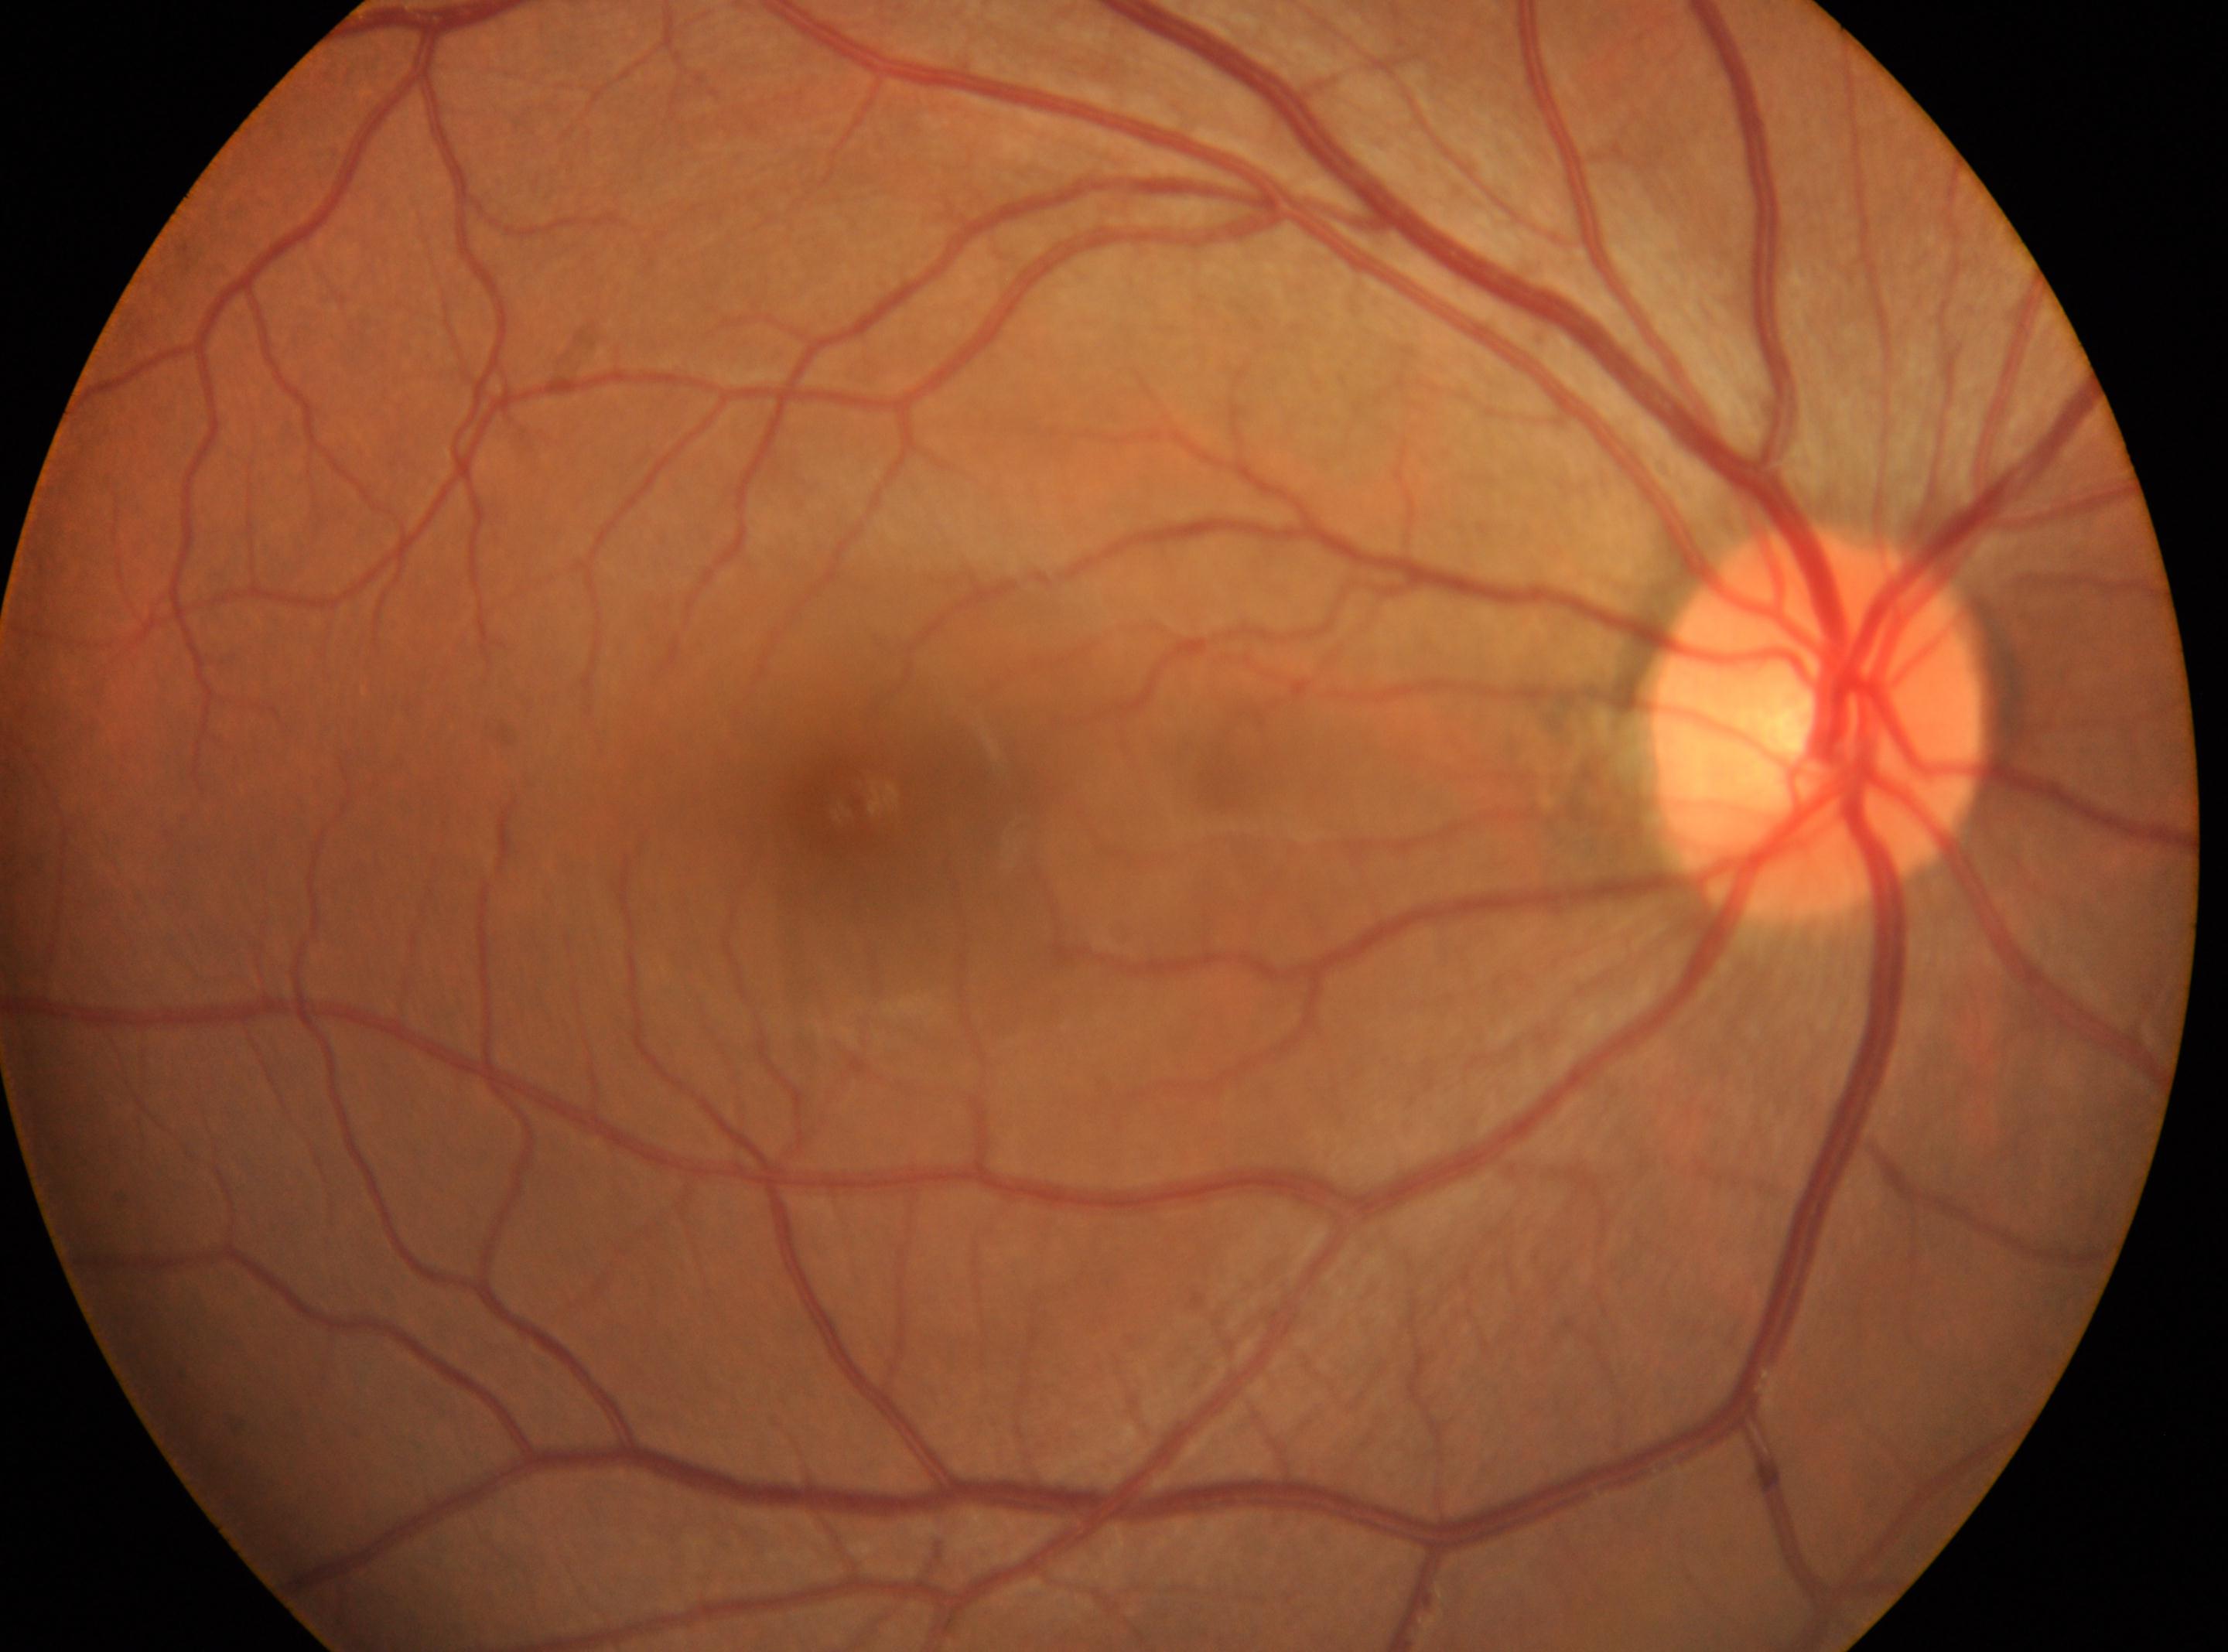 The macula center is at (857, 800). This is the OD. Diabetic retinopathy (DR): no apparent diabetic retinopathy (grade 0). Disc center: (1820, 722).